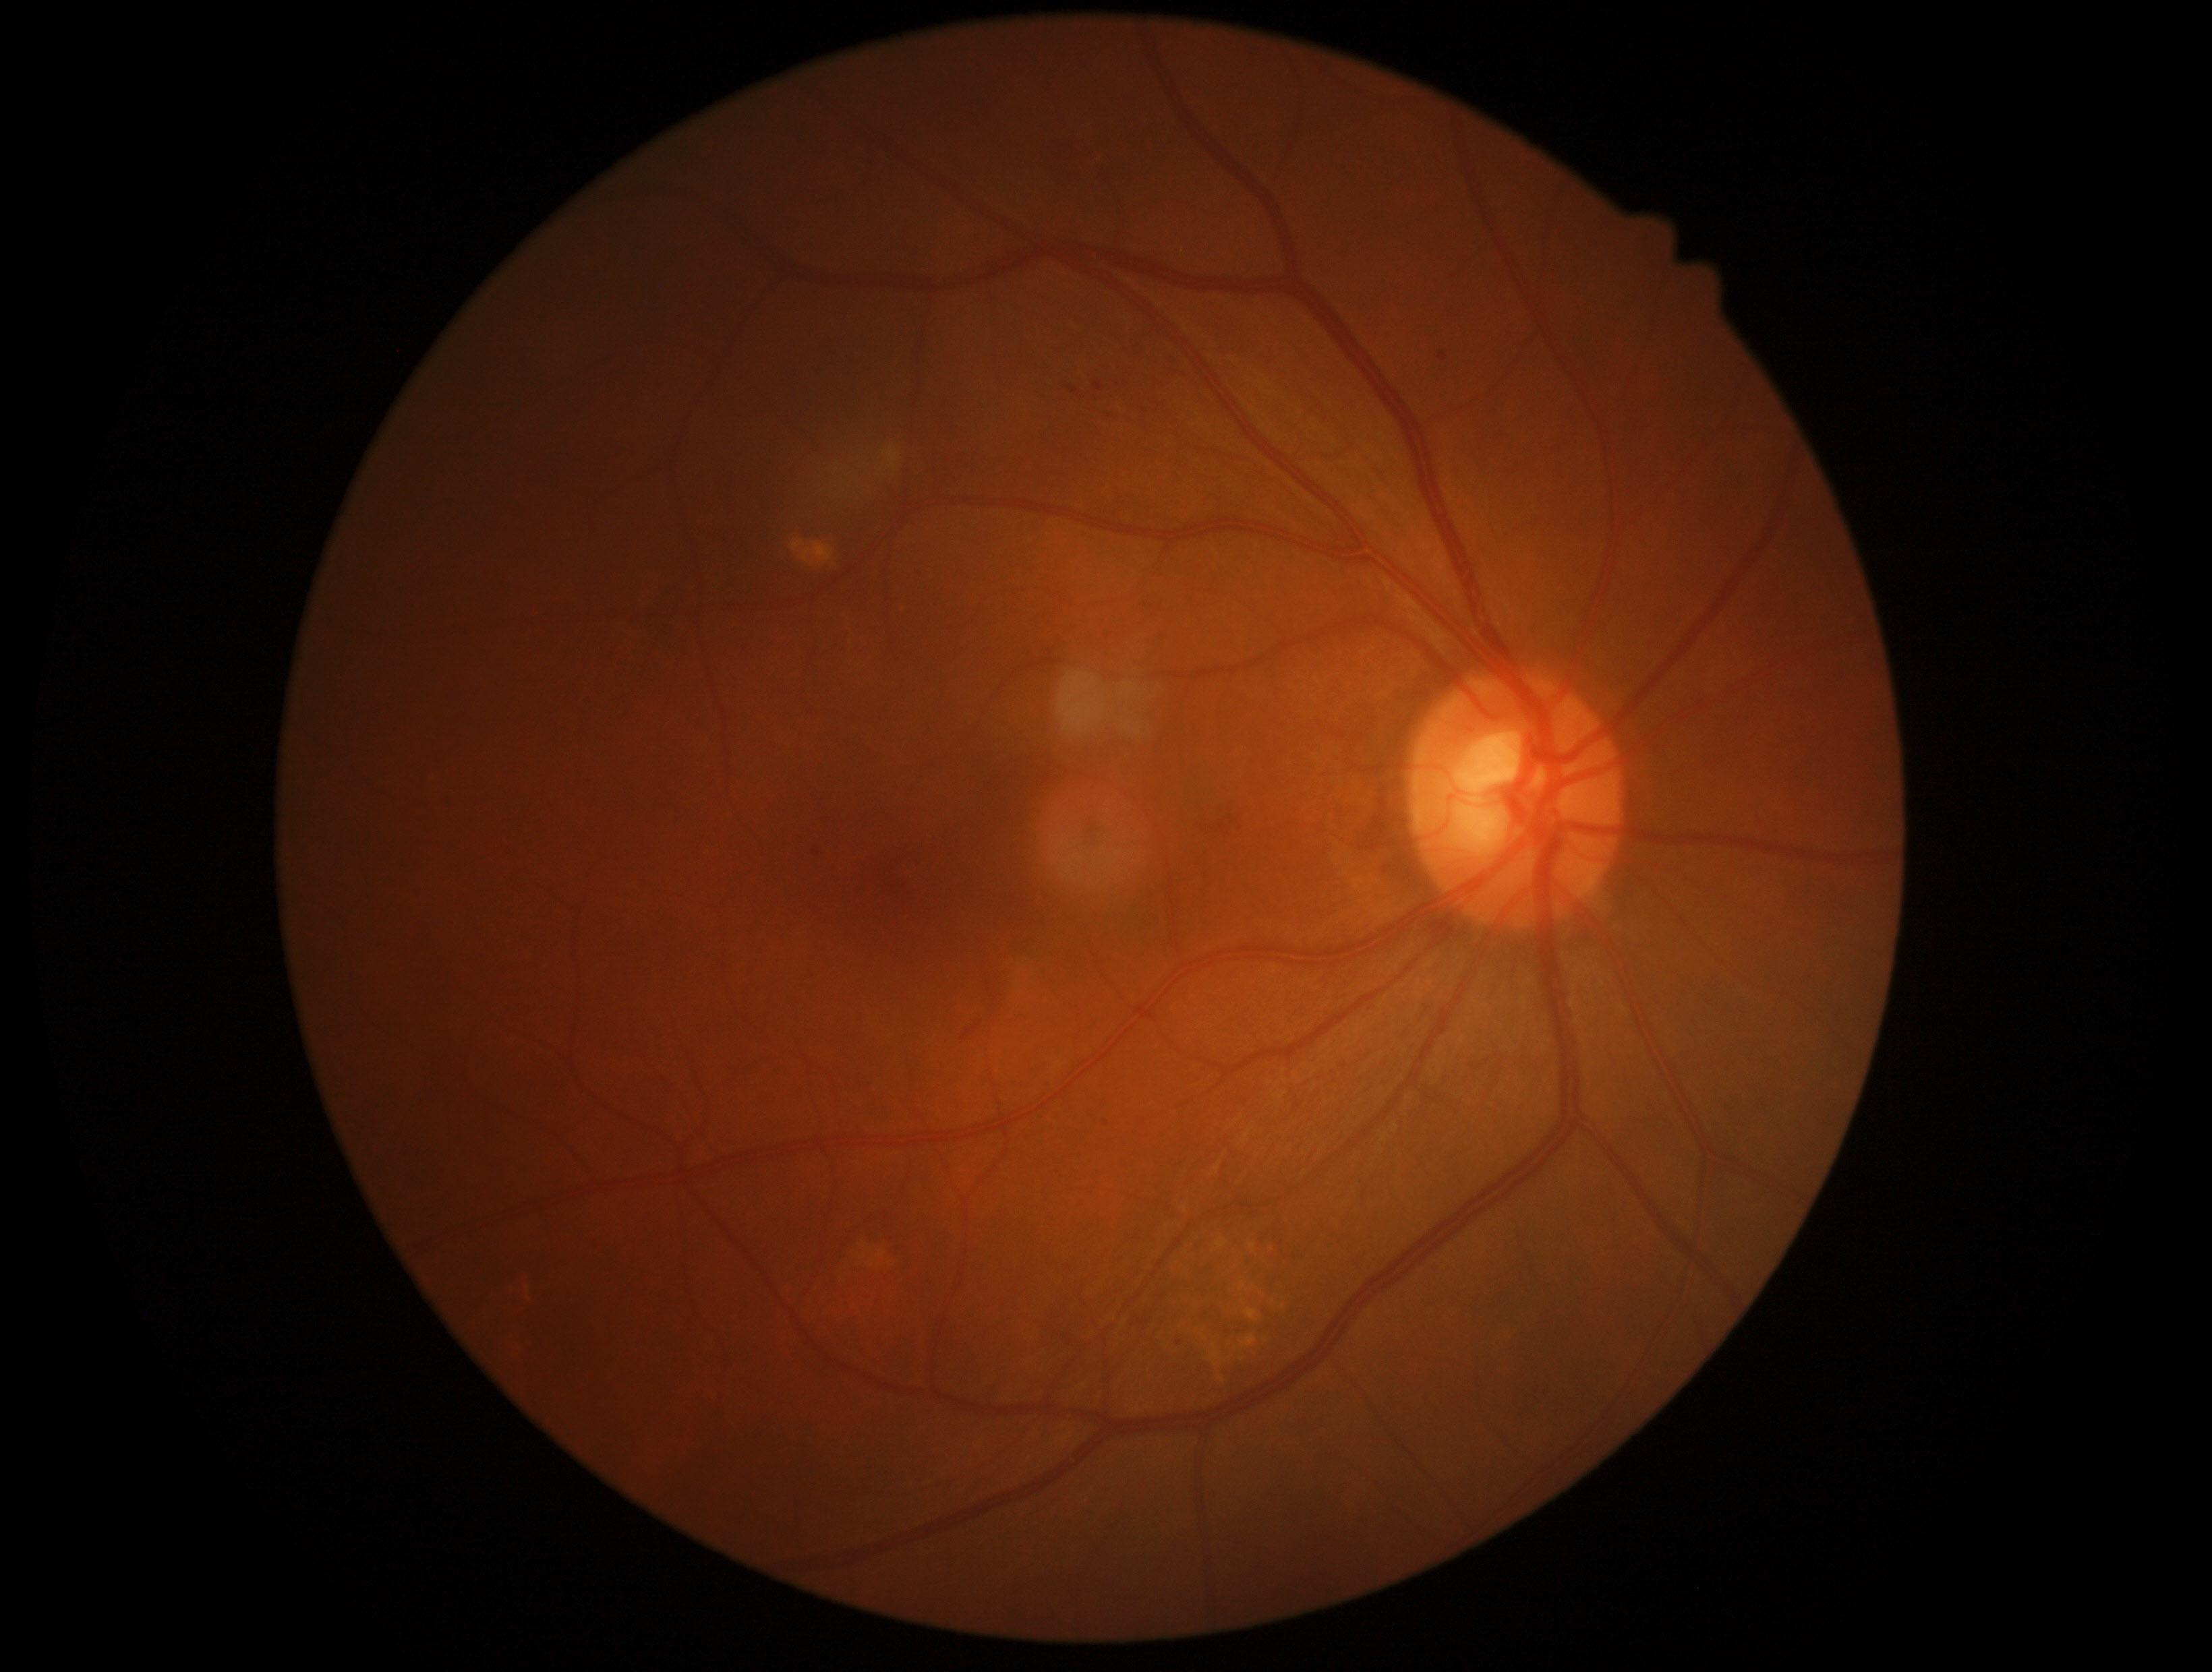

DR severity: grade 2 (moderate NPDR).